FOV: 45 degrees. Color fundus photograph.
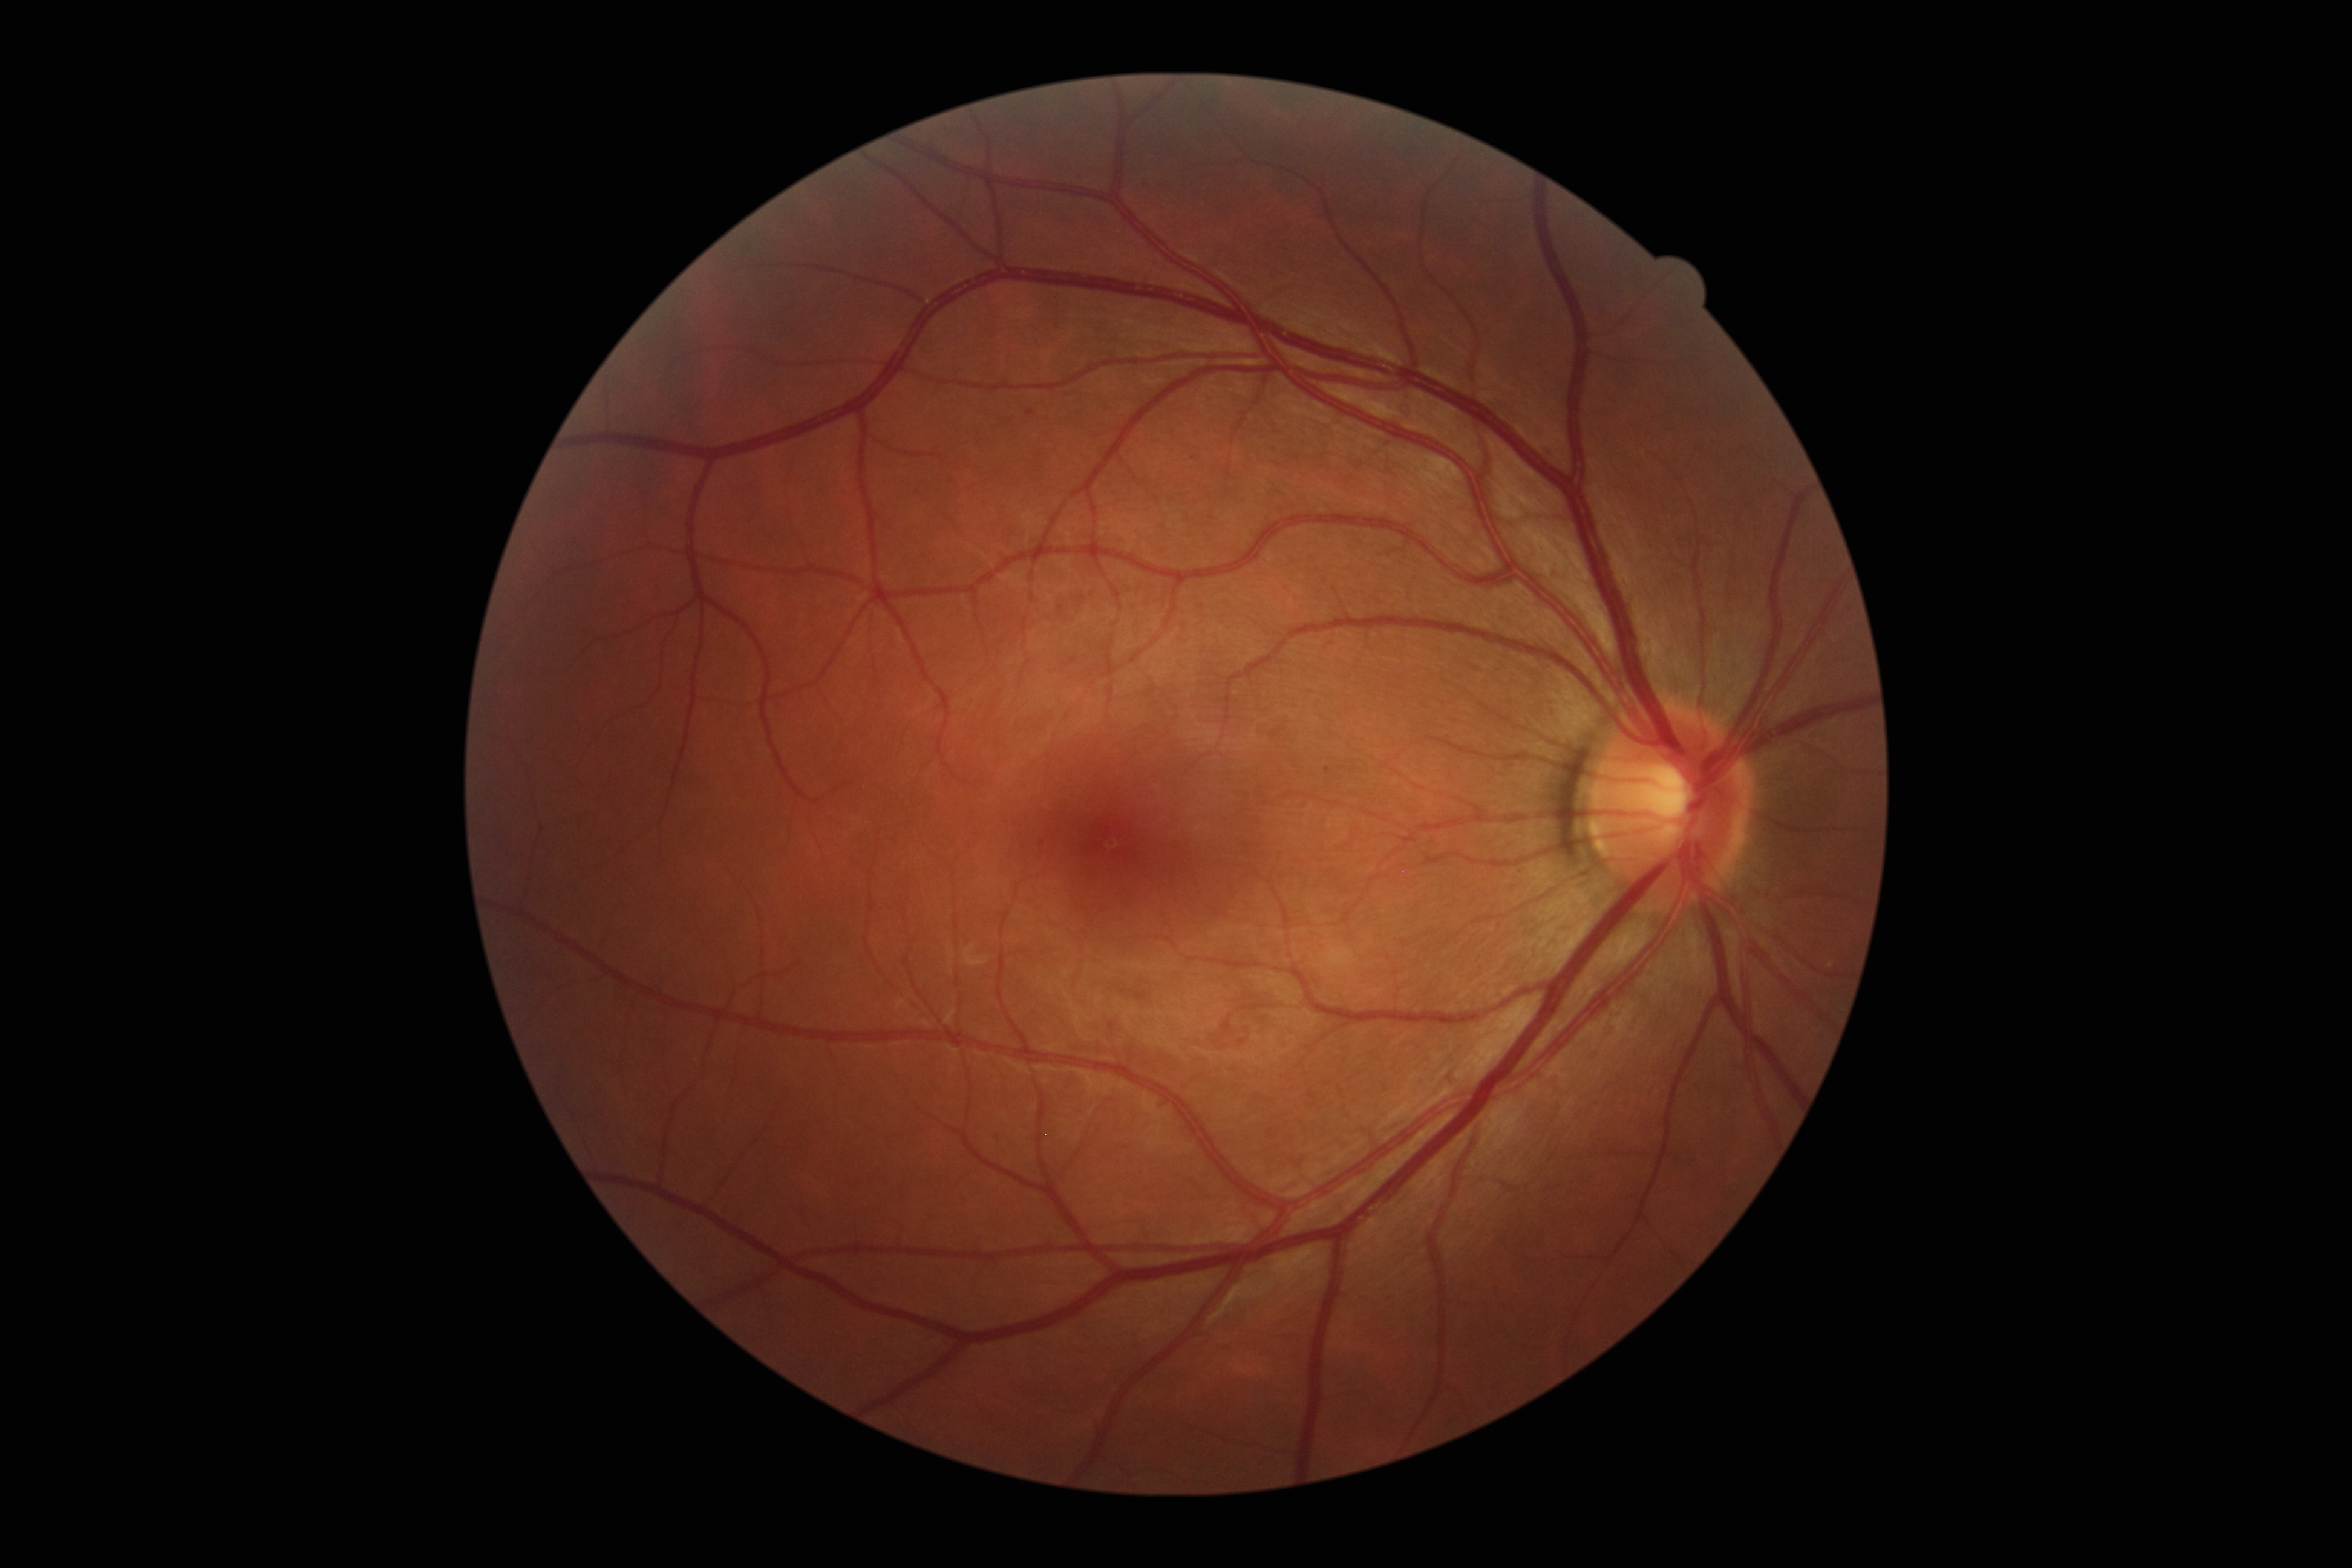 DR stage is grade 1 (mild NPDR) — presence of microaneurysms only. Disease class: non-proliferative diabetic retinopathy.